FOV: 45 degrees
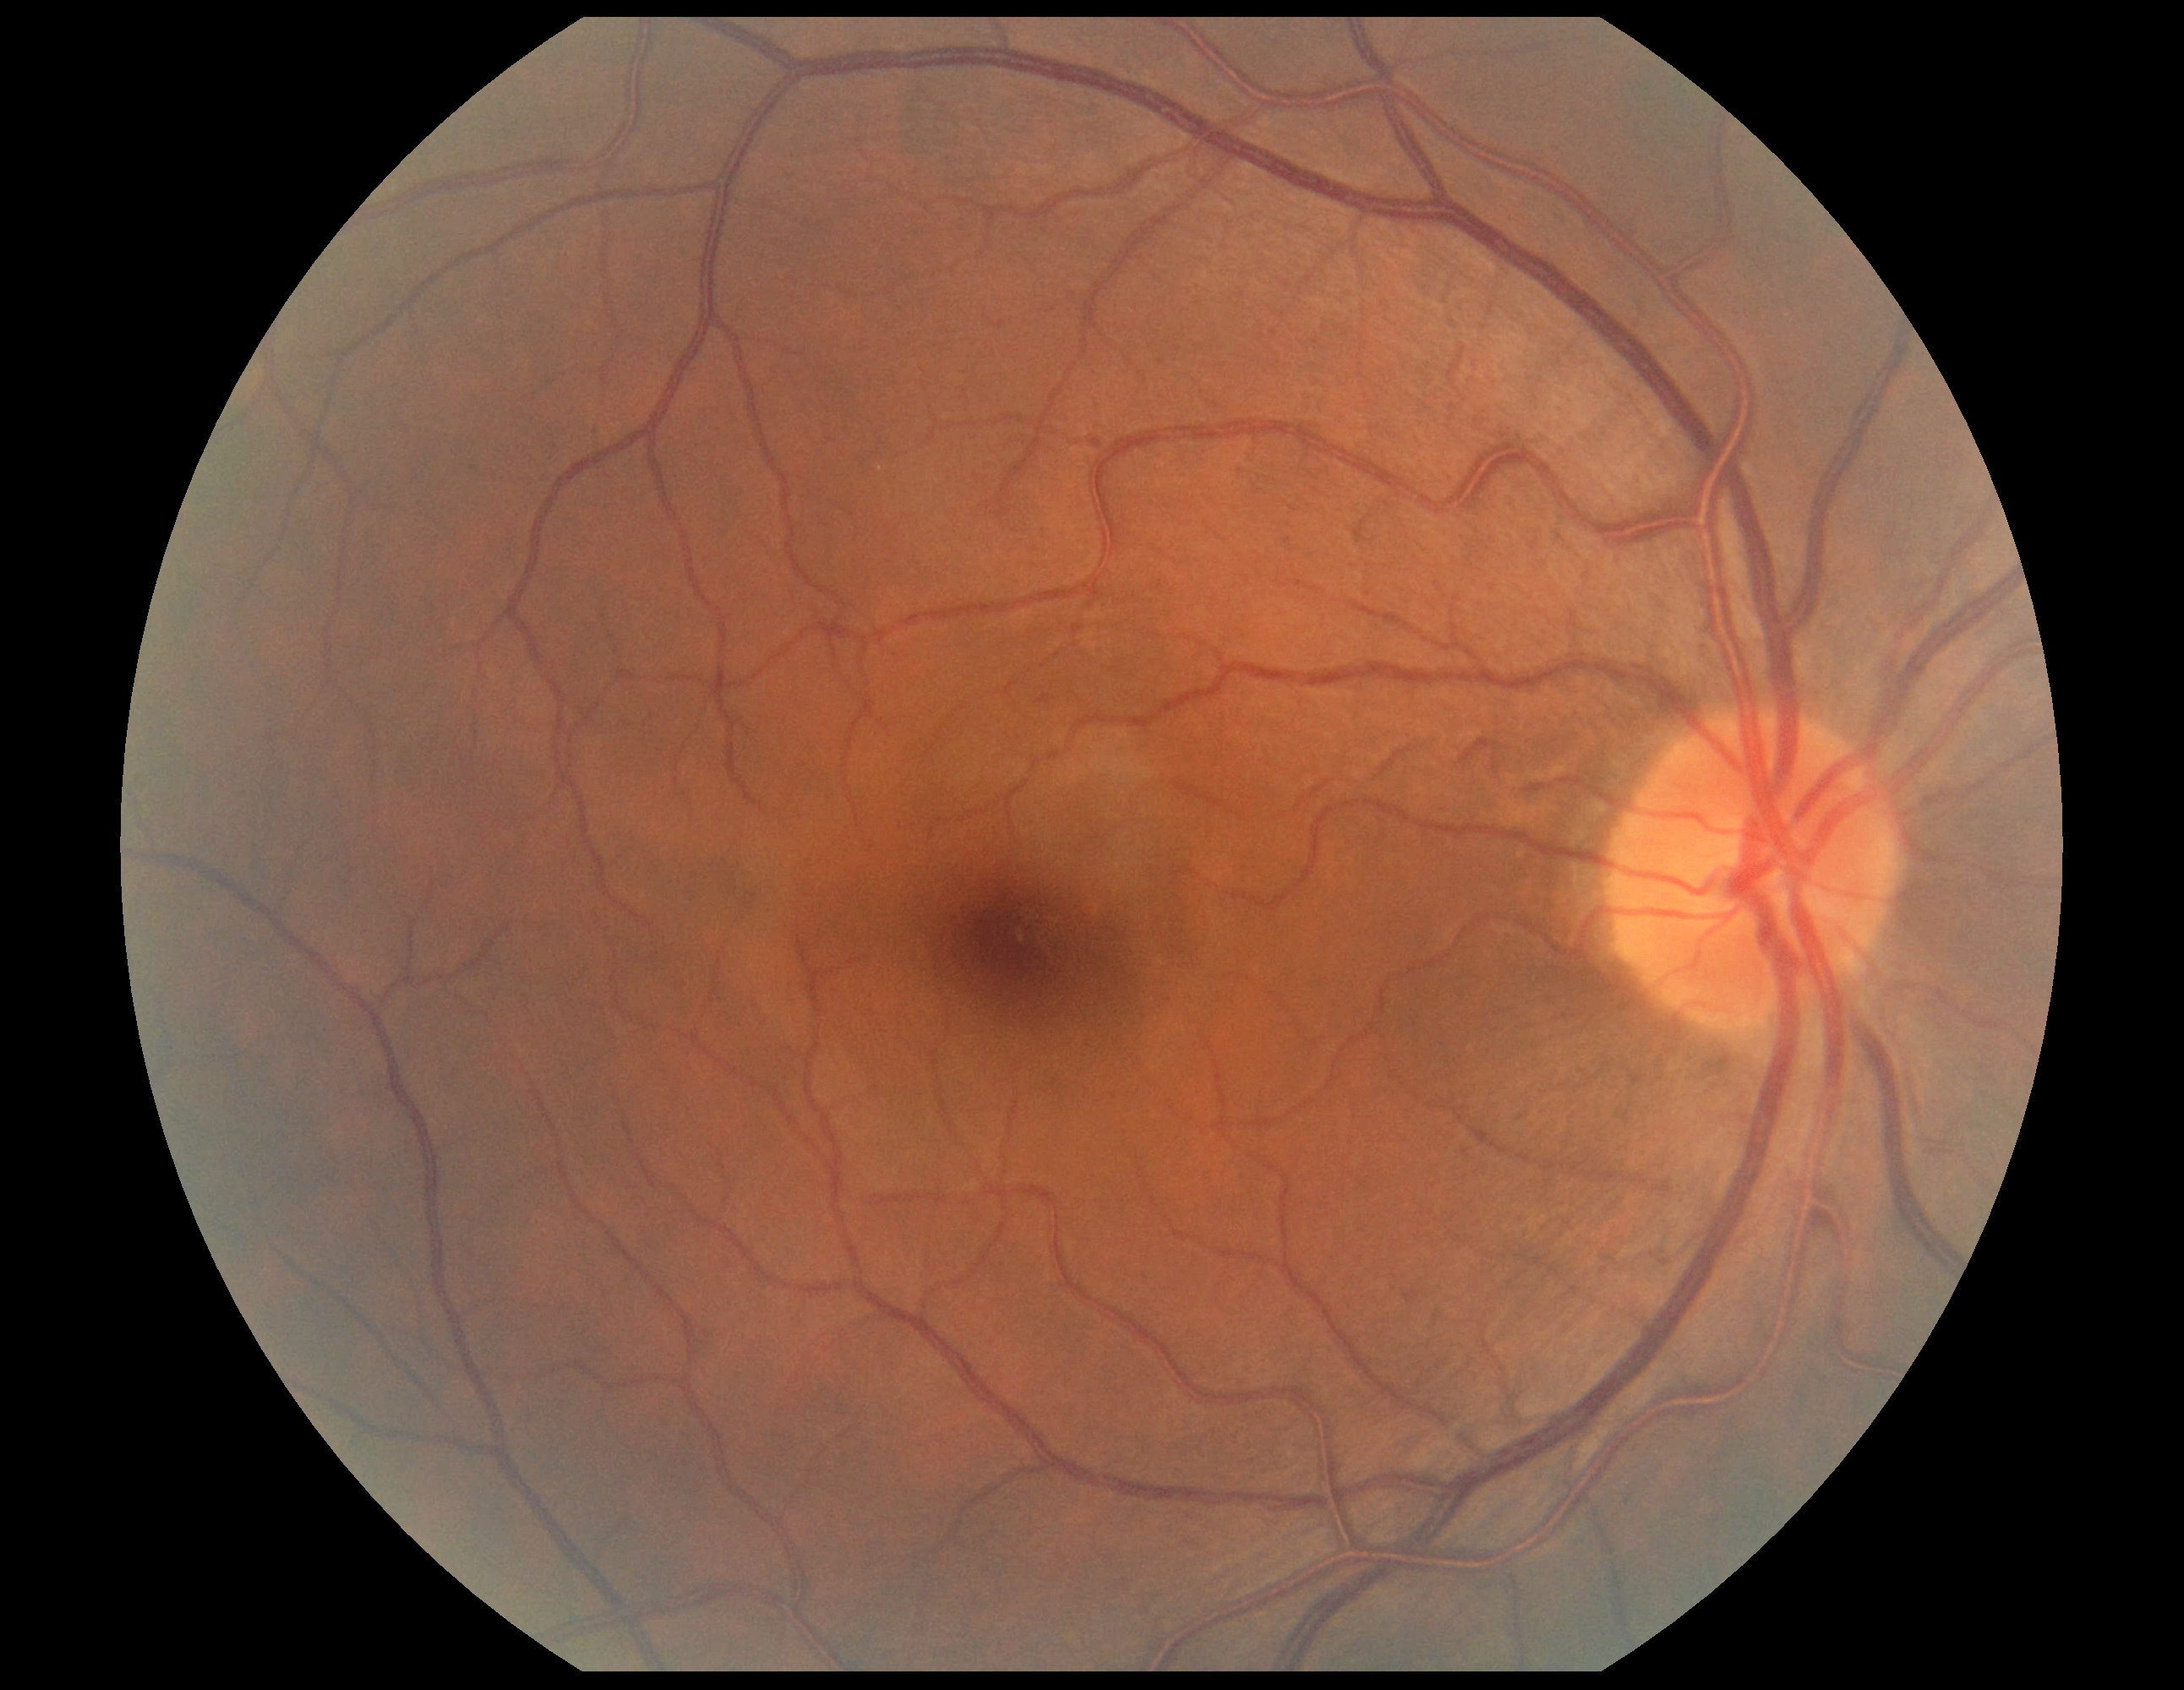 Diabetic retinopathy (DR) is no apparent retinopathy (grade 0) — no visible signs of diabetic retinopathy.